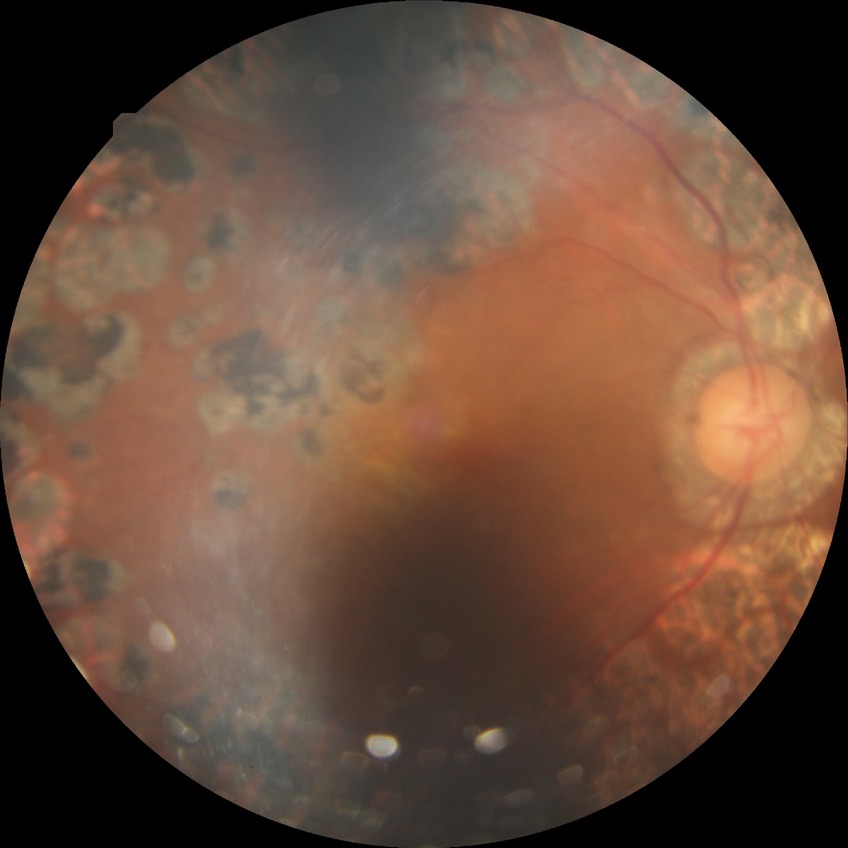
  davis_grade: PDR (proliferative diabetic retinopathy)